NIDEK AFC-230 fundus camera; modified Davis classification; 45-degree field of view; posterior pole photograph:
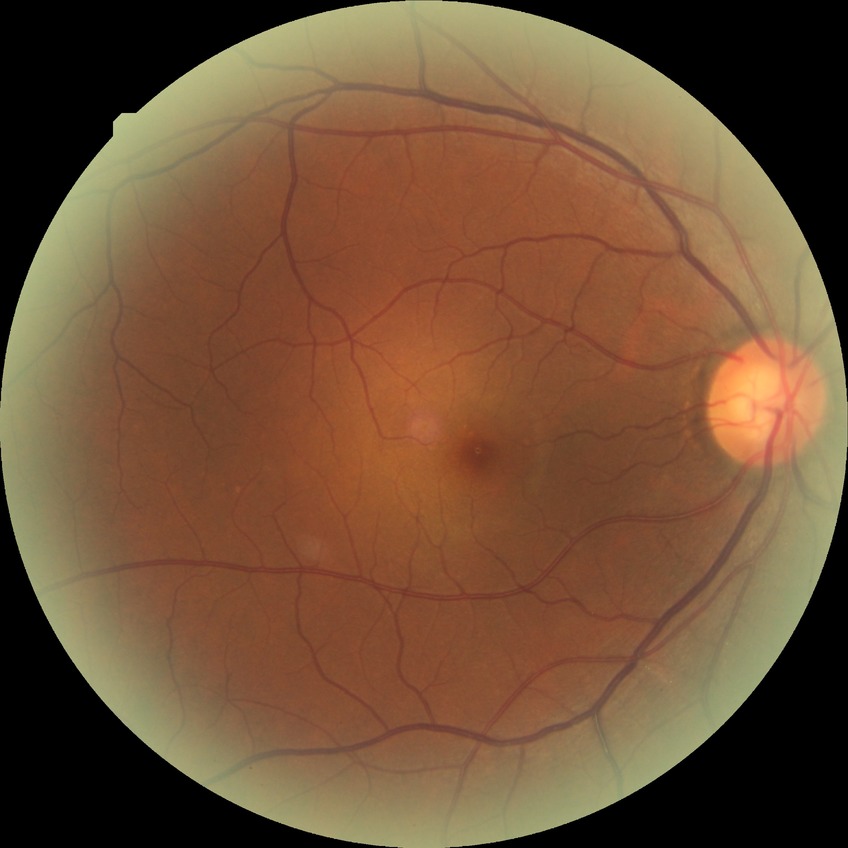
Diabetic retinopathy (DR): no diabetic retinopathy (NDR).